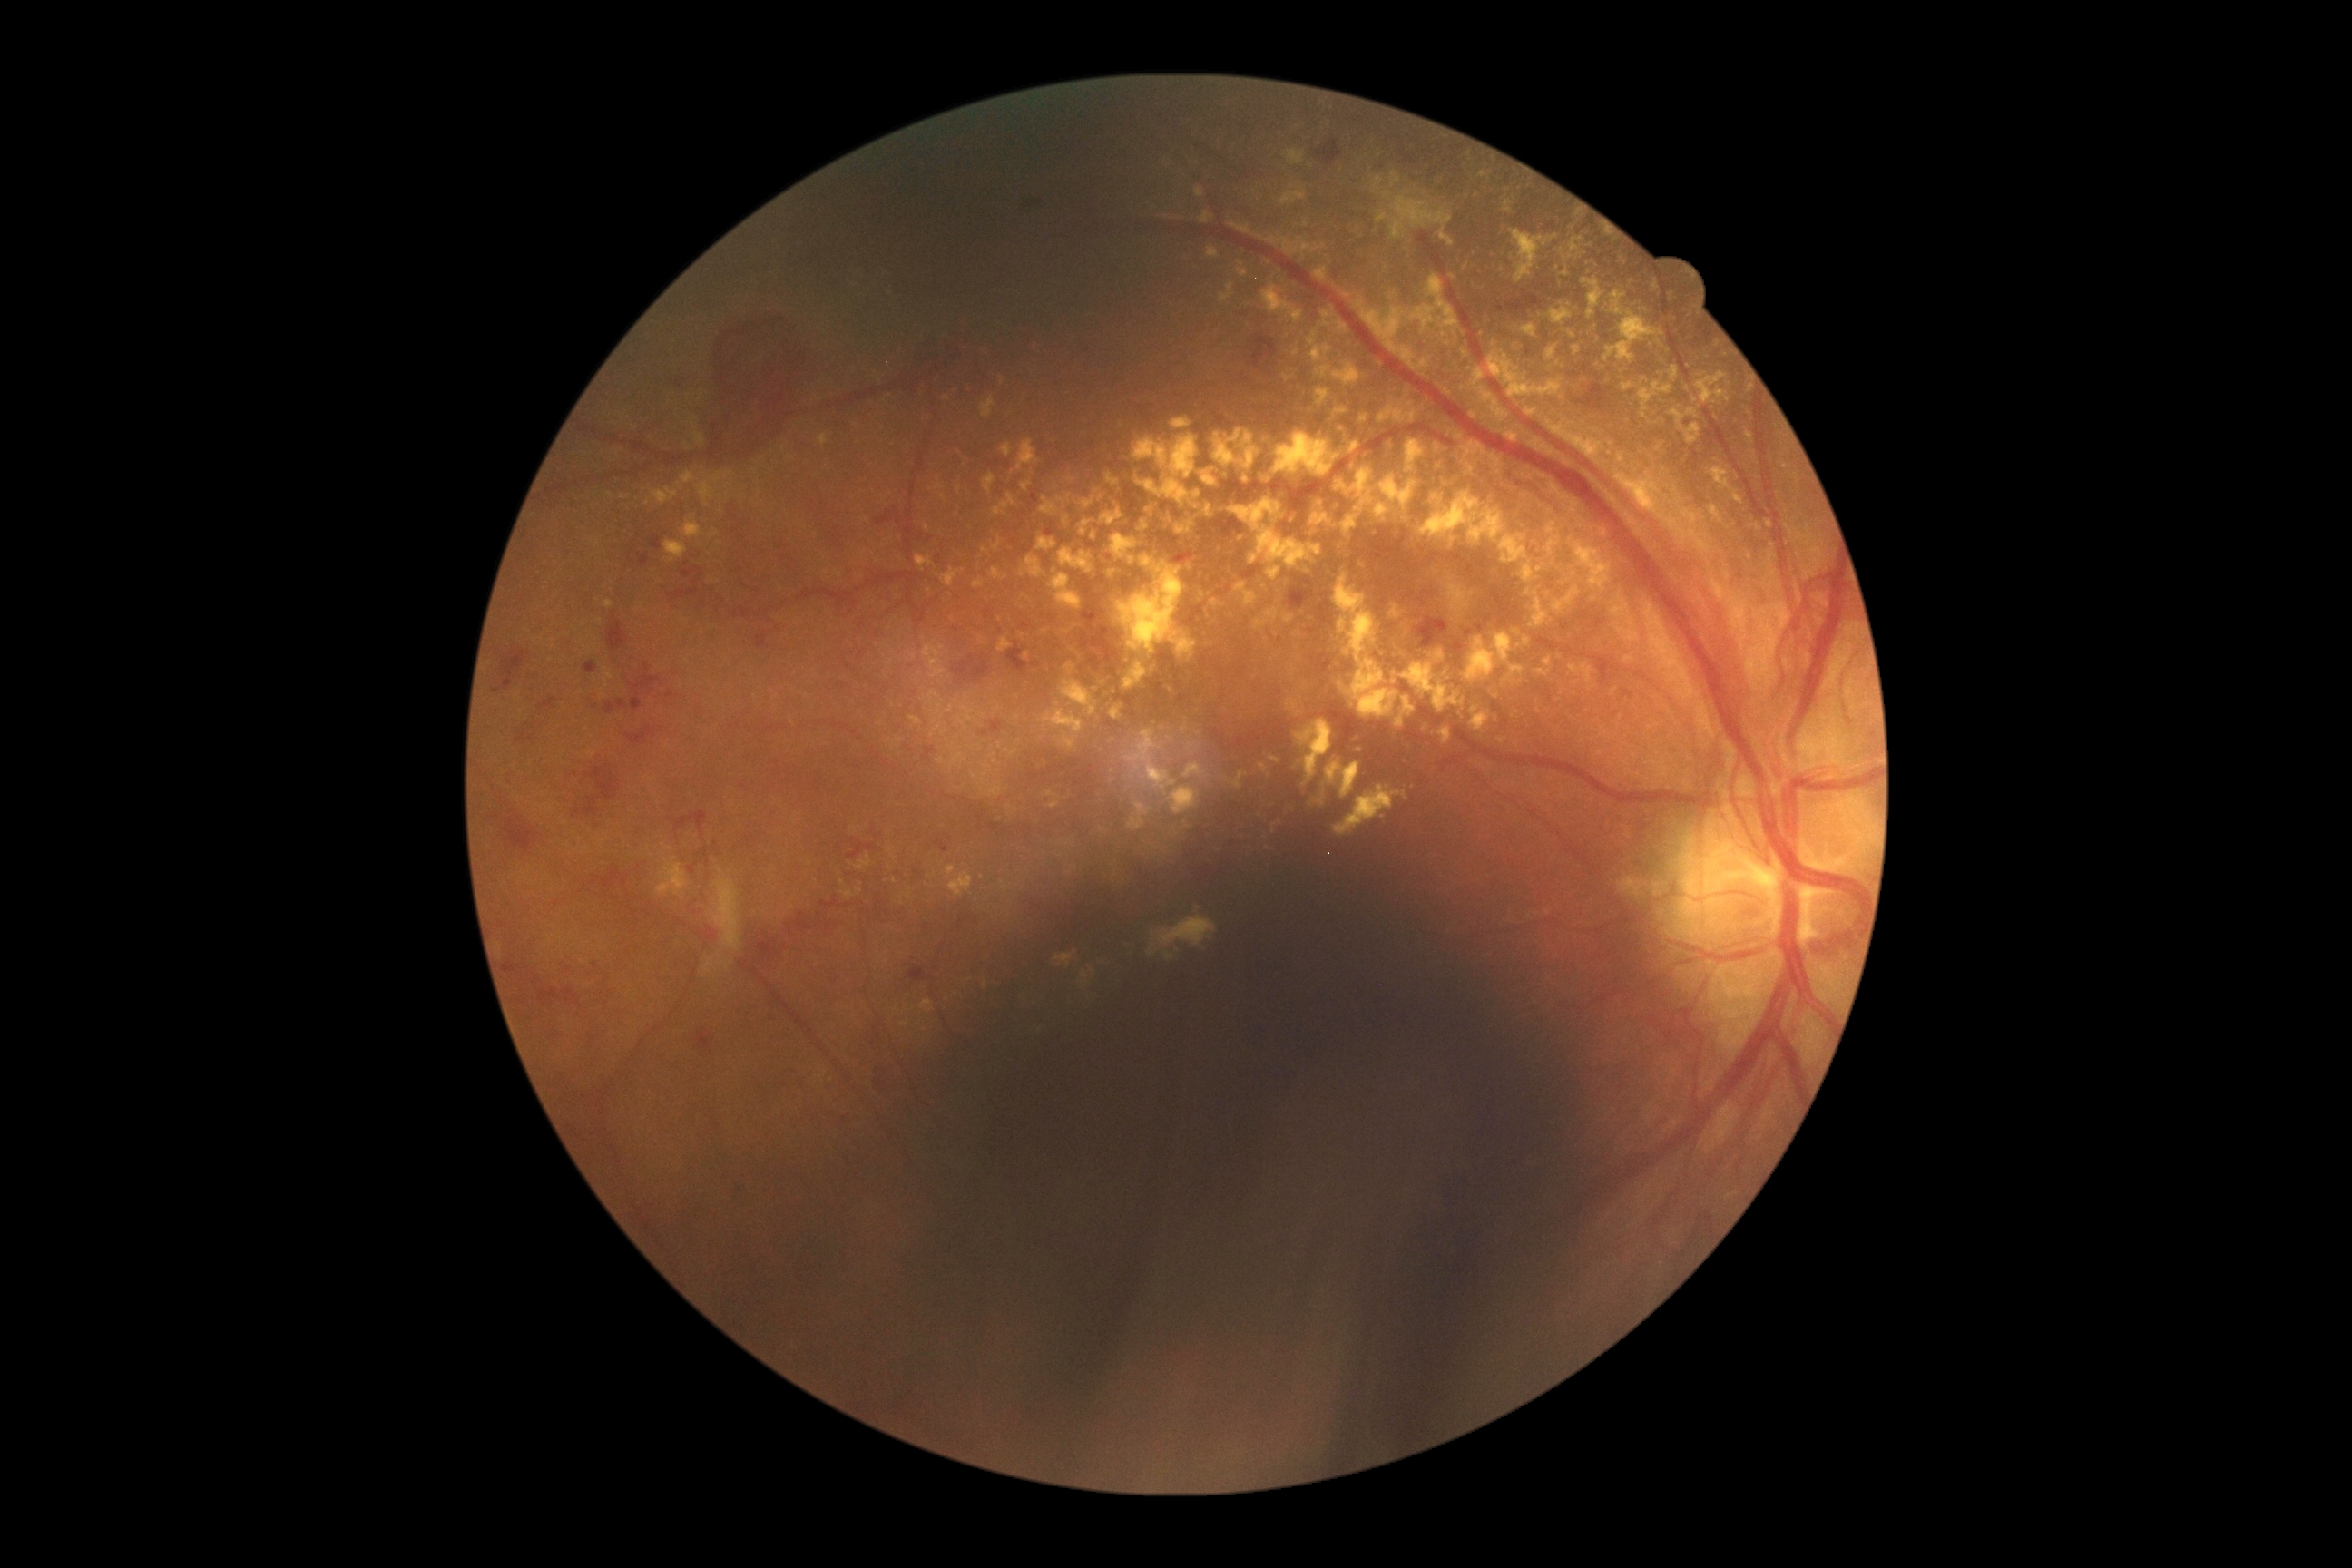

DR grade: proliferative diabetic retinopathy (4).